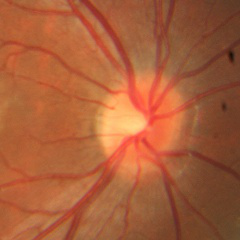

Demonstrates no signs of glaucoma.